Without pupil dilation, modified Davis classification, NIDEK AFC-230:
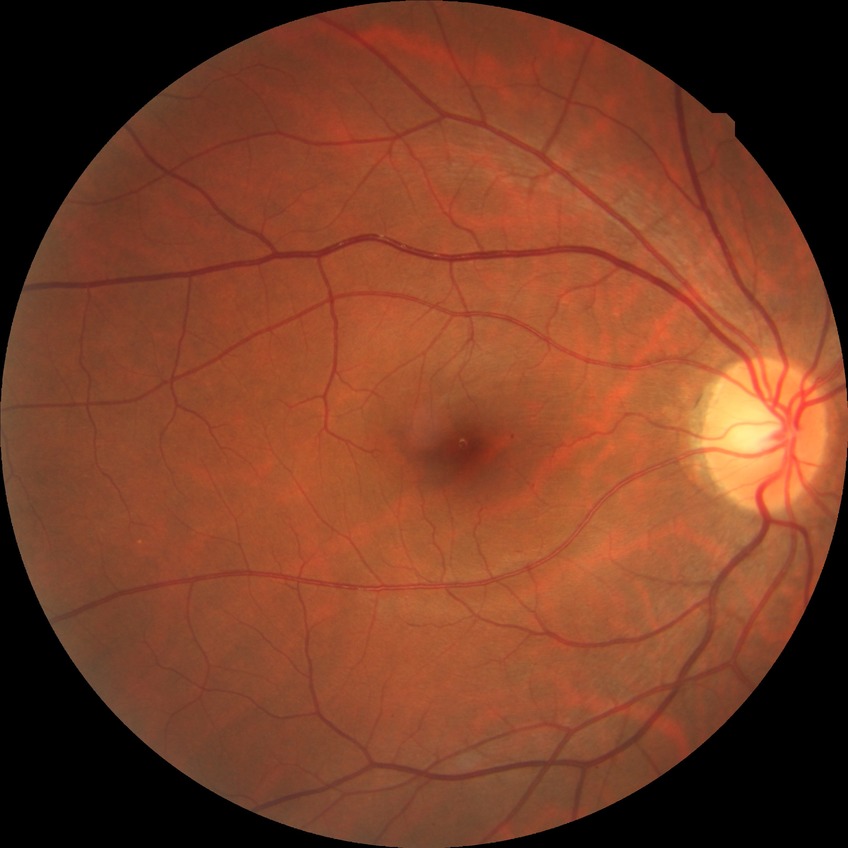

Modified Davis classification is simple diabetic retinopathy.